Without pupil dilation, 848 x 848 pixels, posterior pole photograph, 45 degree fundus photograph: 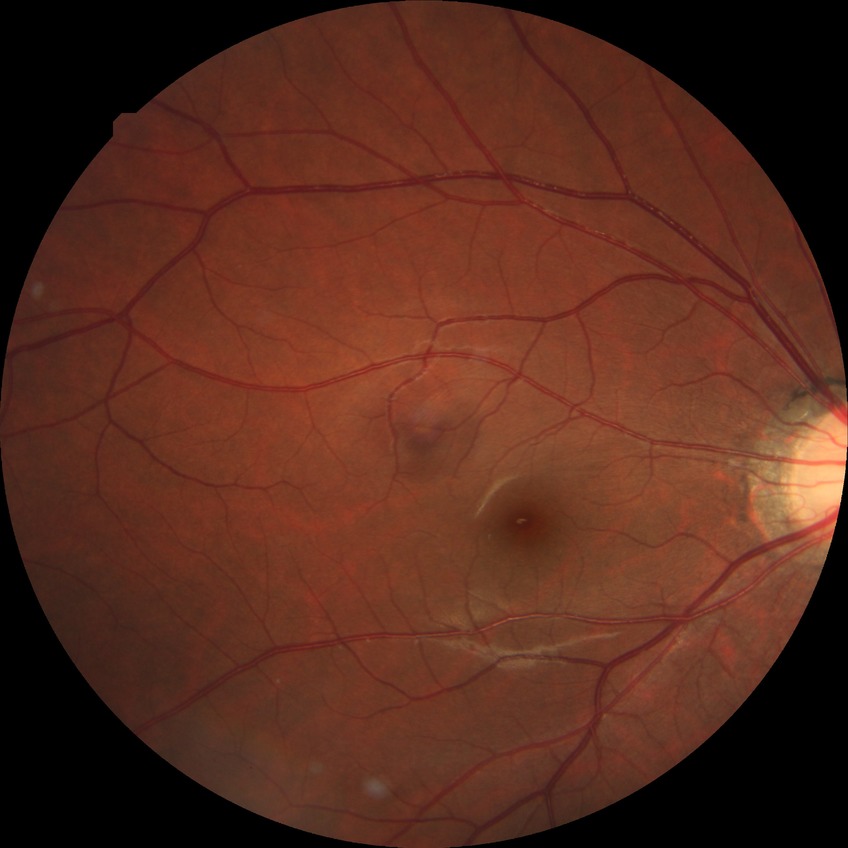

  davis_grade: no diabetic retinopathy (NDR)